45° field of view, 412 by 310 pixels, tabletop color fundus camera image.
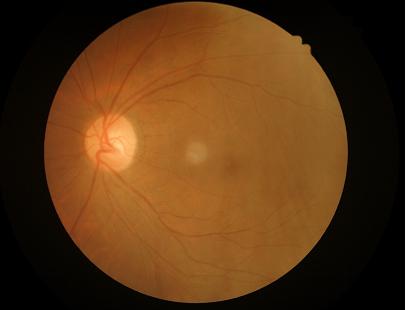 Contrast is good. The image is clear. Overall image quality is good.